Captured with the Phoenix ICON (100° field of view) · pediatric wide-field fundus photograph.
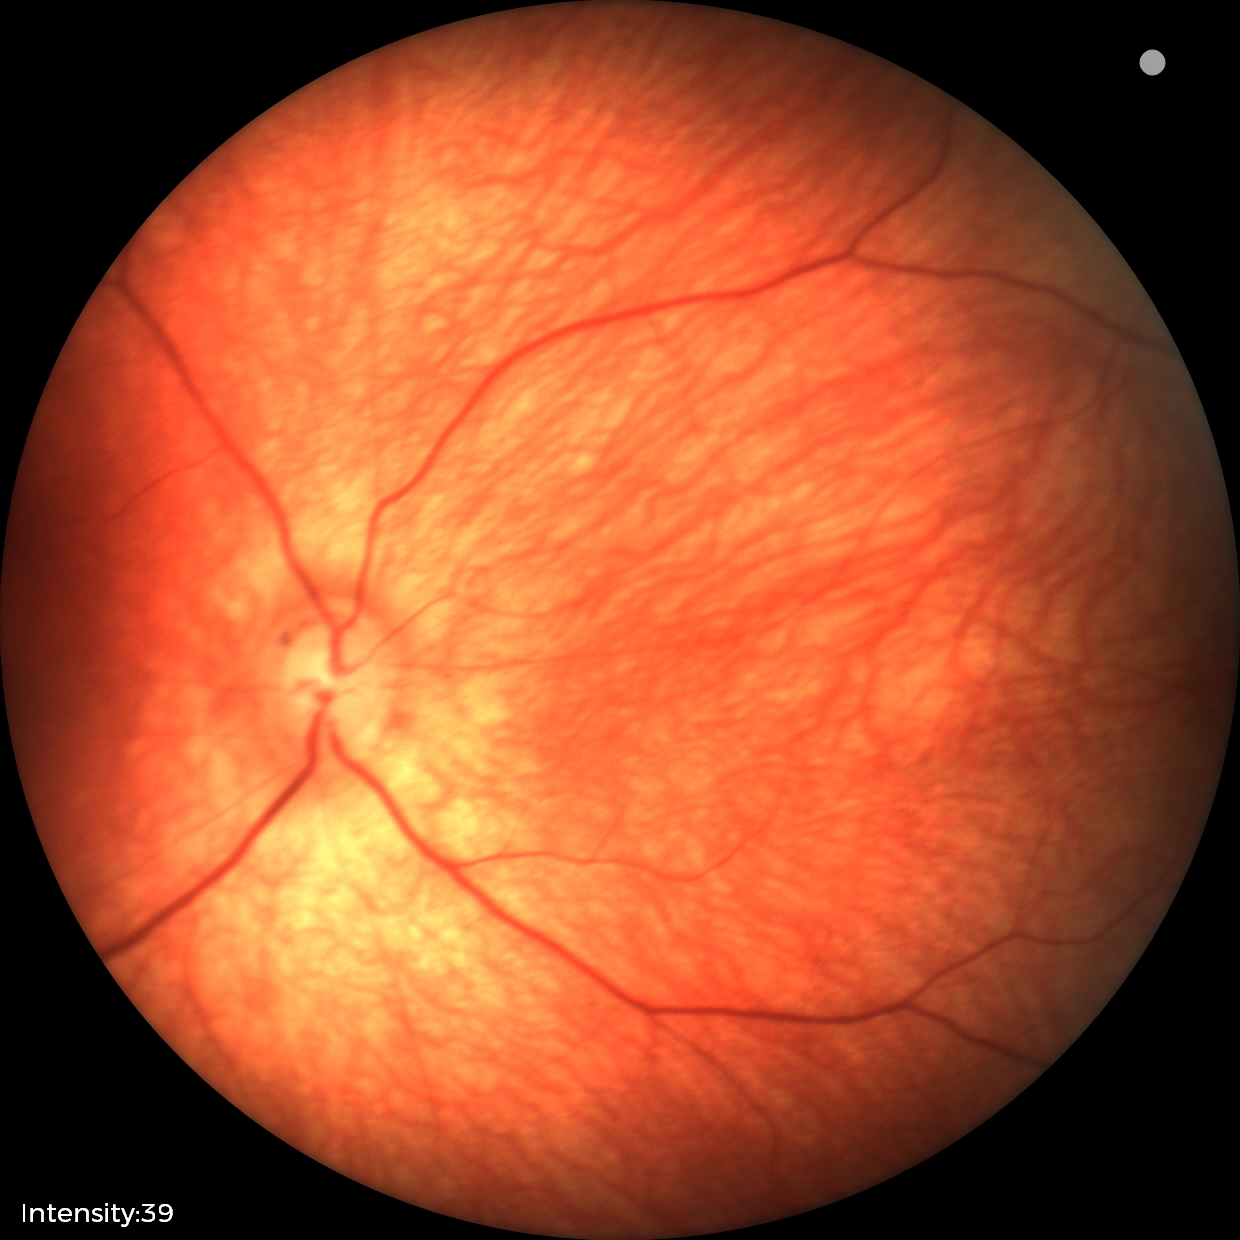

Finding: physiological.